CFP — 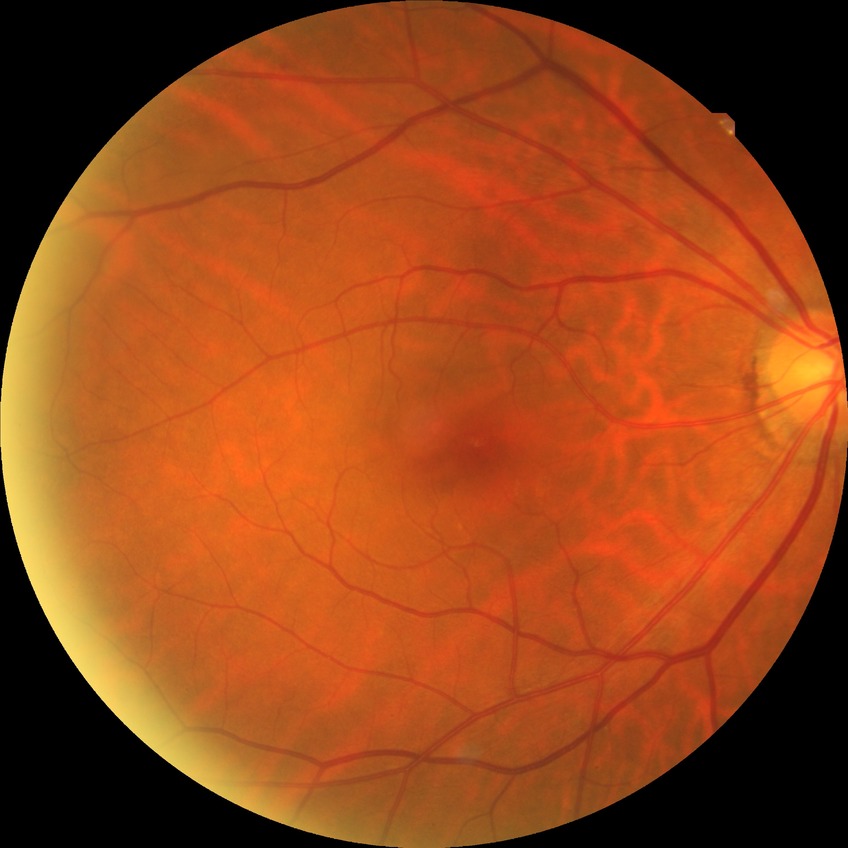

modified Davis grading: no diabetic retinopathy.